Fundus photo. Acquired with a Forus 3Nethra fundus camera.
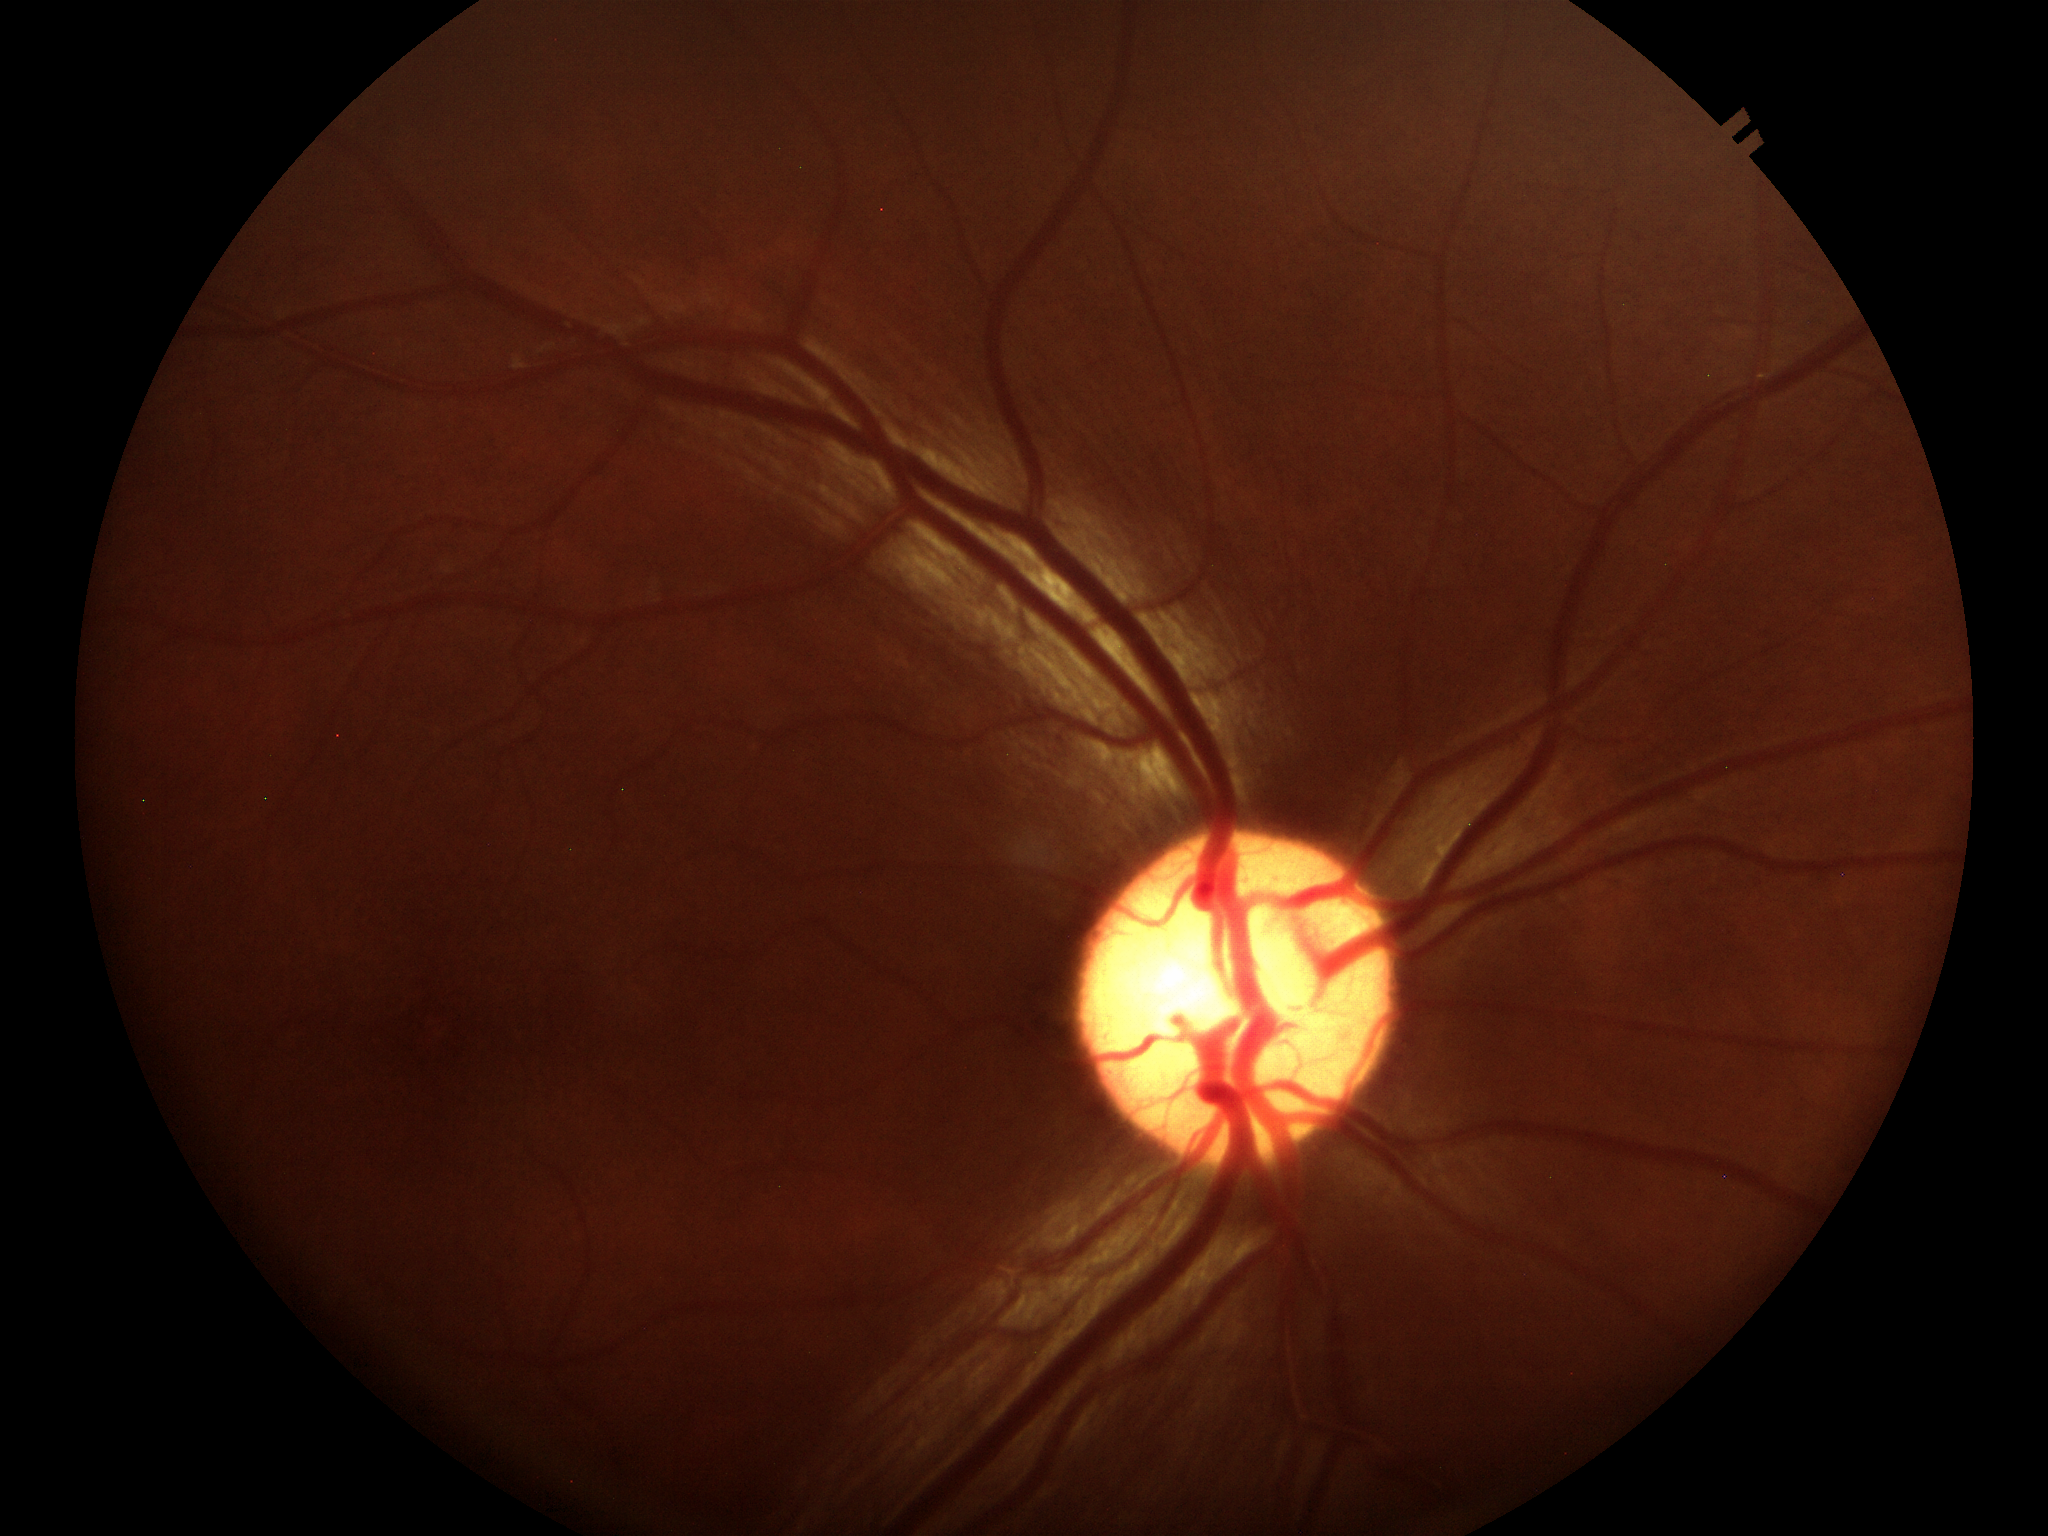
No glaucomatous optic neuropathy (2 of 5 graders flagged glaucoma suspect). Vertical cup-to-disc ratio (VCDR): 0.55.